Color fundus photograph; 1932 x 1932 pixels; 45-degree field of view — 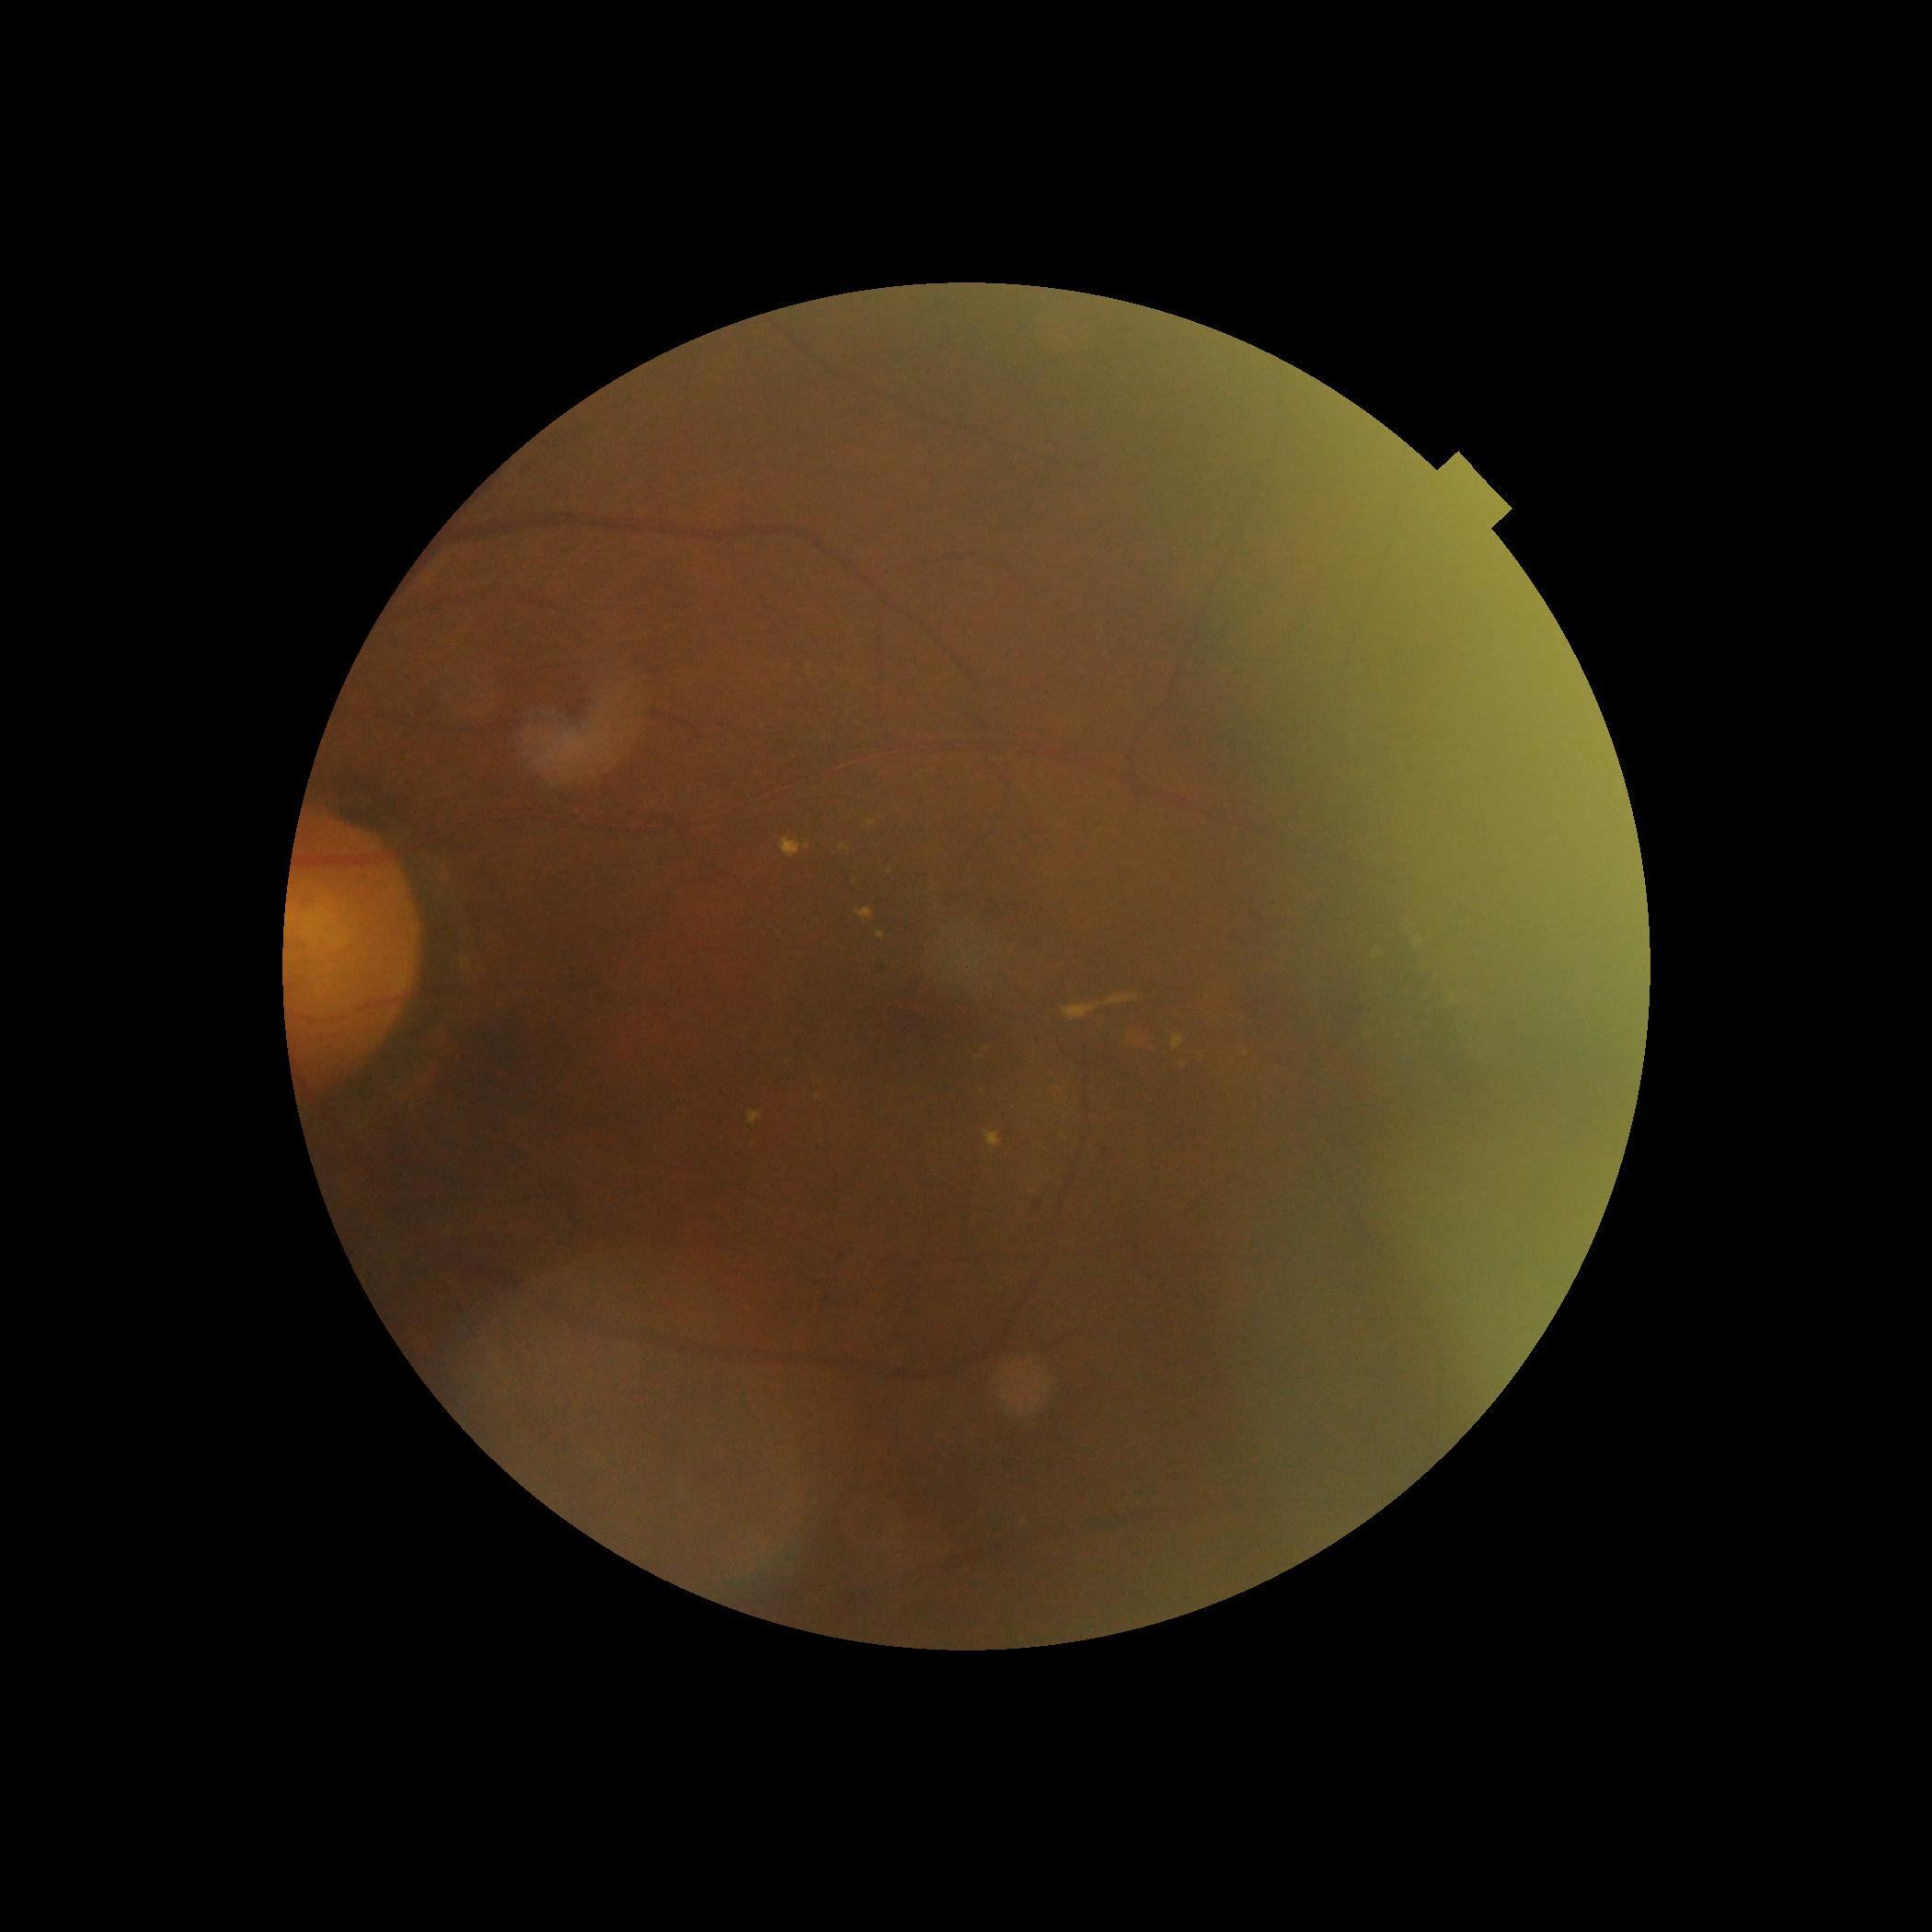

{
  "dr_grade": "2/4",
  "dr_category": "non-proliferative diabetic retinopathy"
}